Color fundus image, 2212 by 1659 pixels, 45-degree field of view.
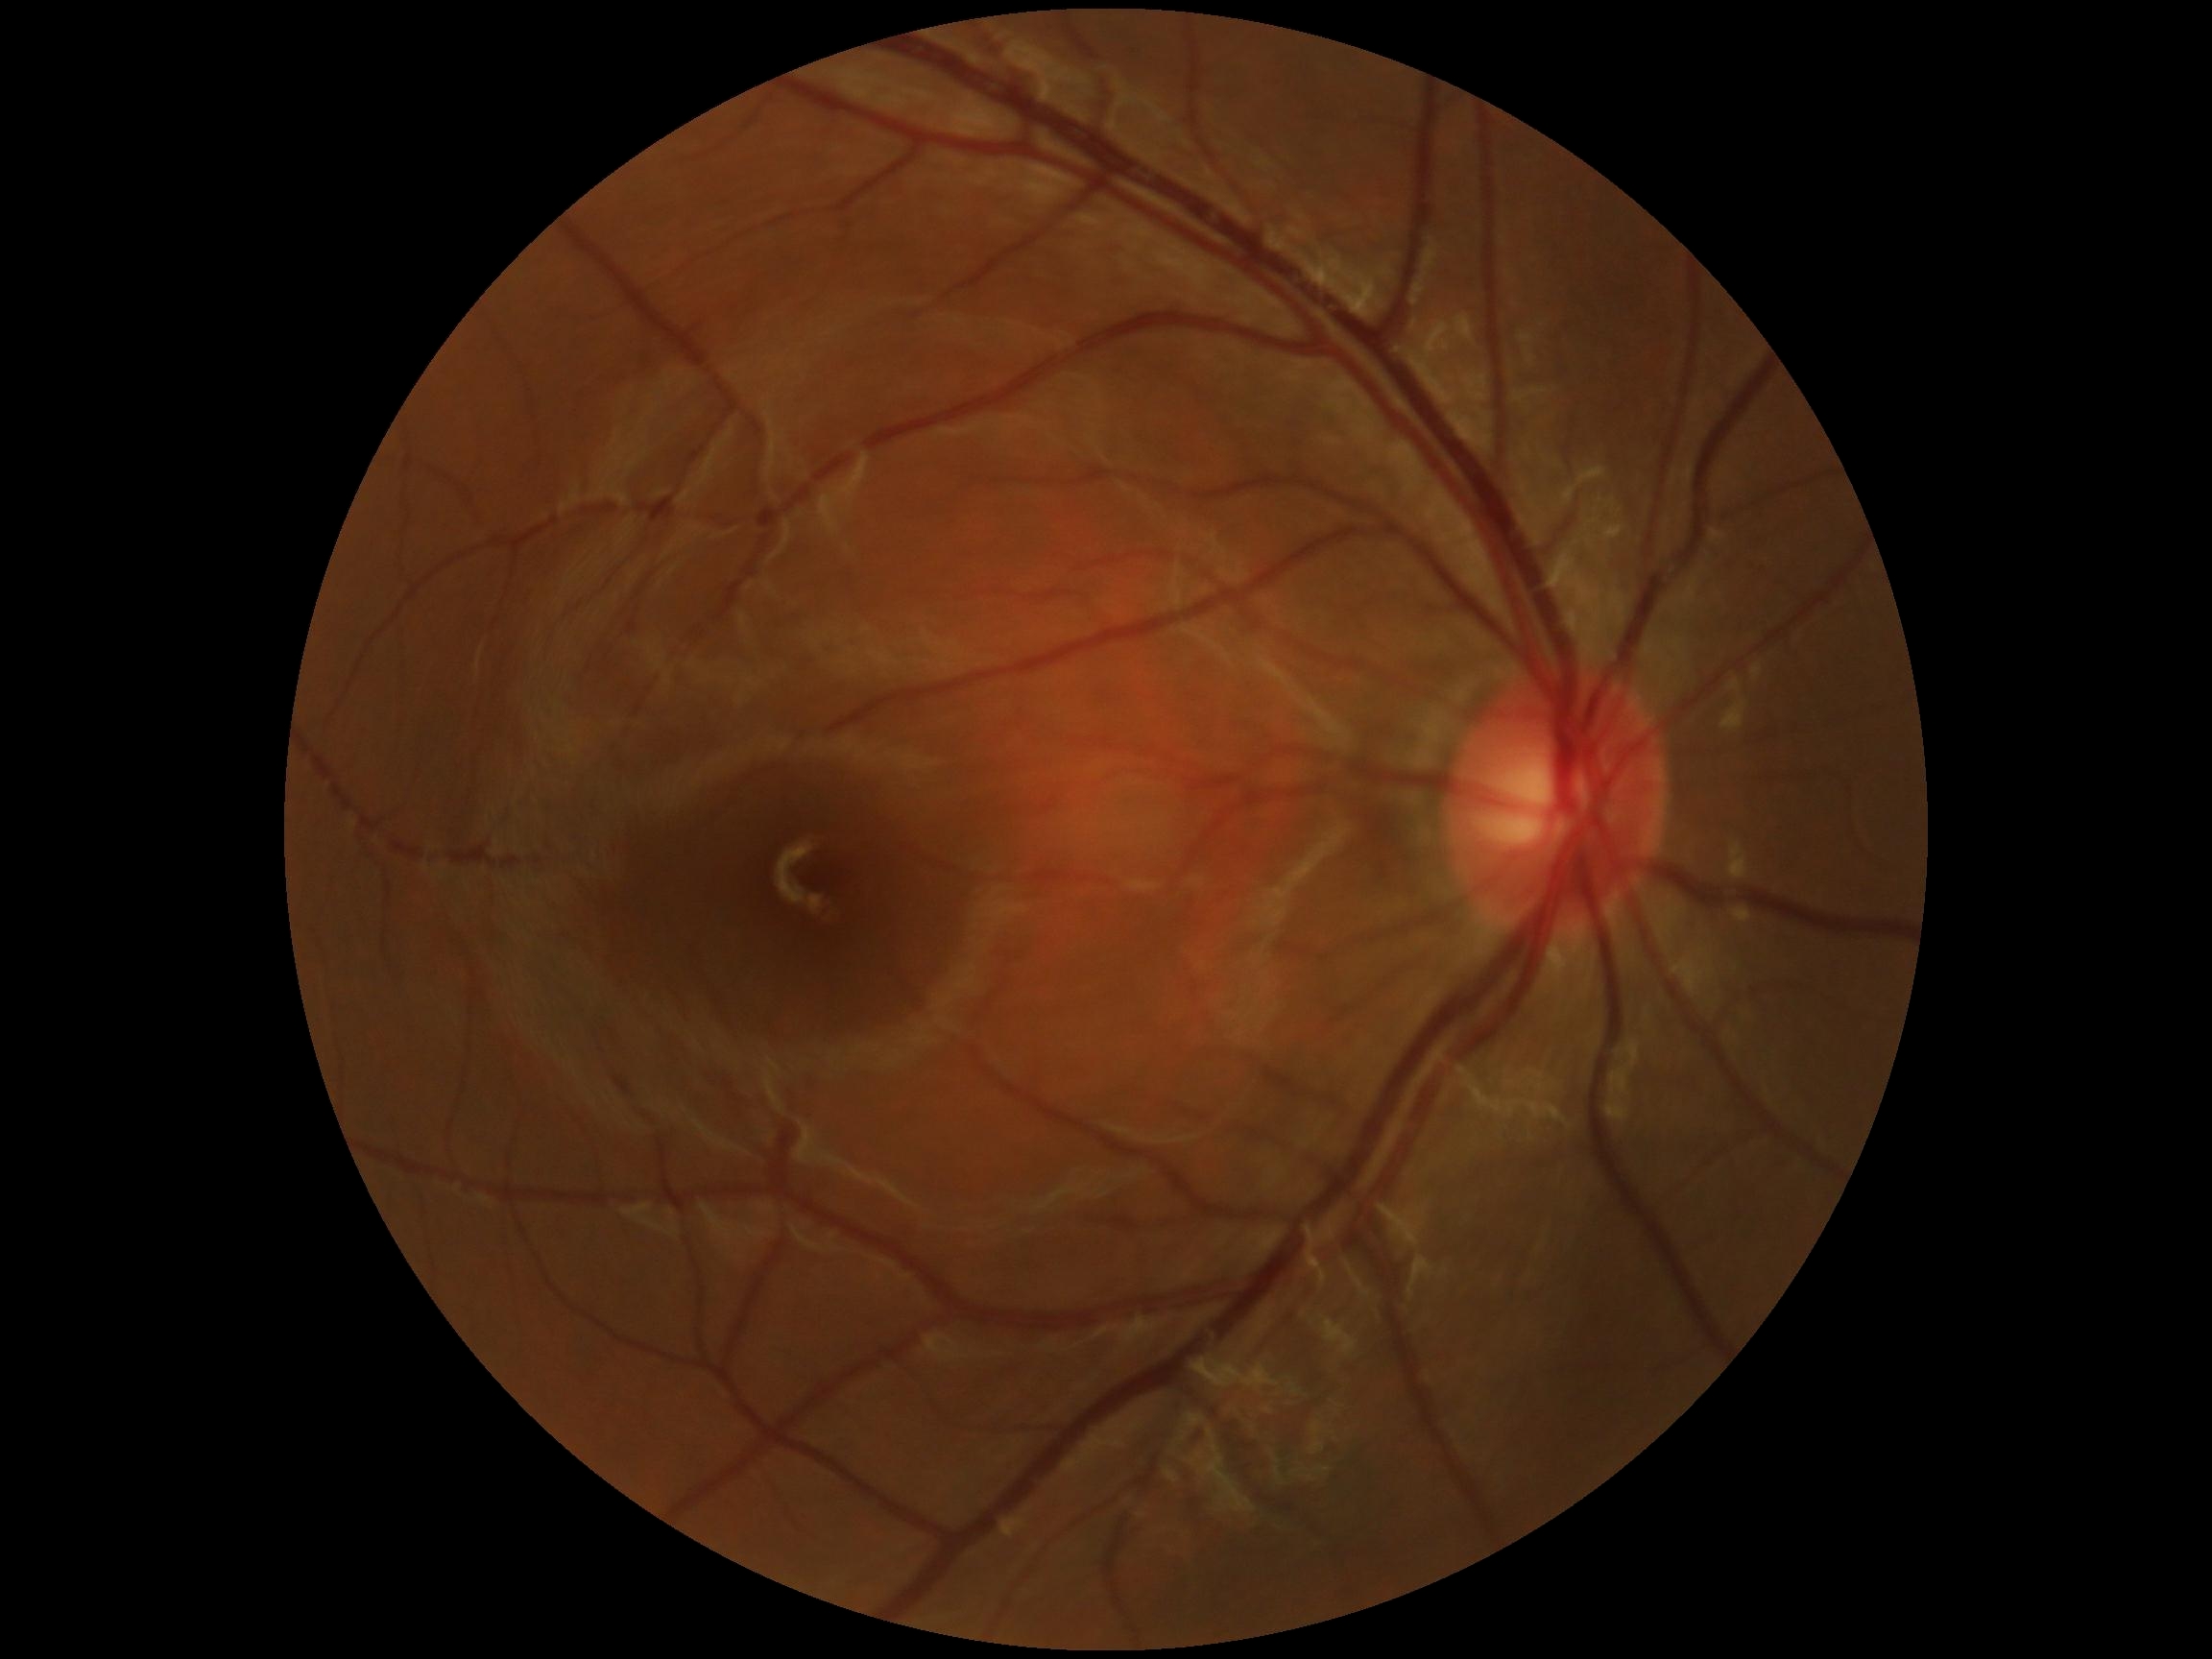
DR grade: no apparent diabetic retinopathy (0) — no visible signs of diabetic retinopathy.